Diabetic retinopathy graded by the modified Davis classification — 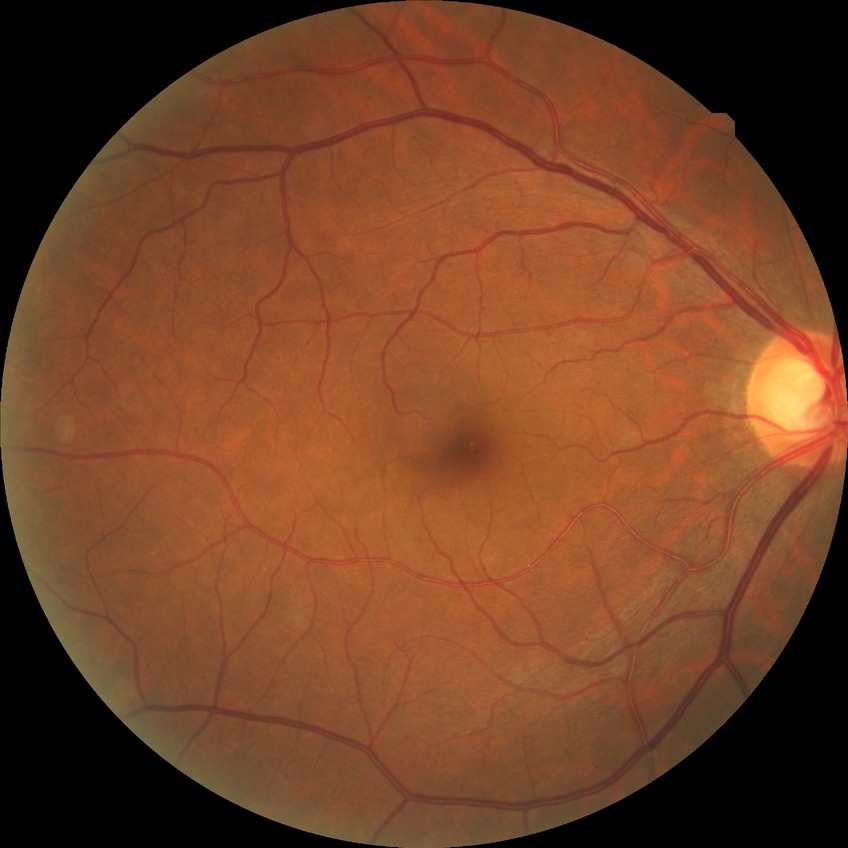
Diabetic retinopathy (DR) is no diabetic retinopathy (NDR).